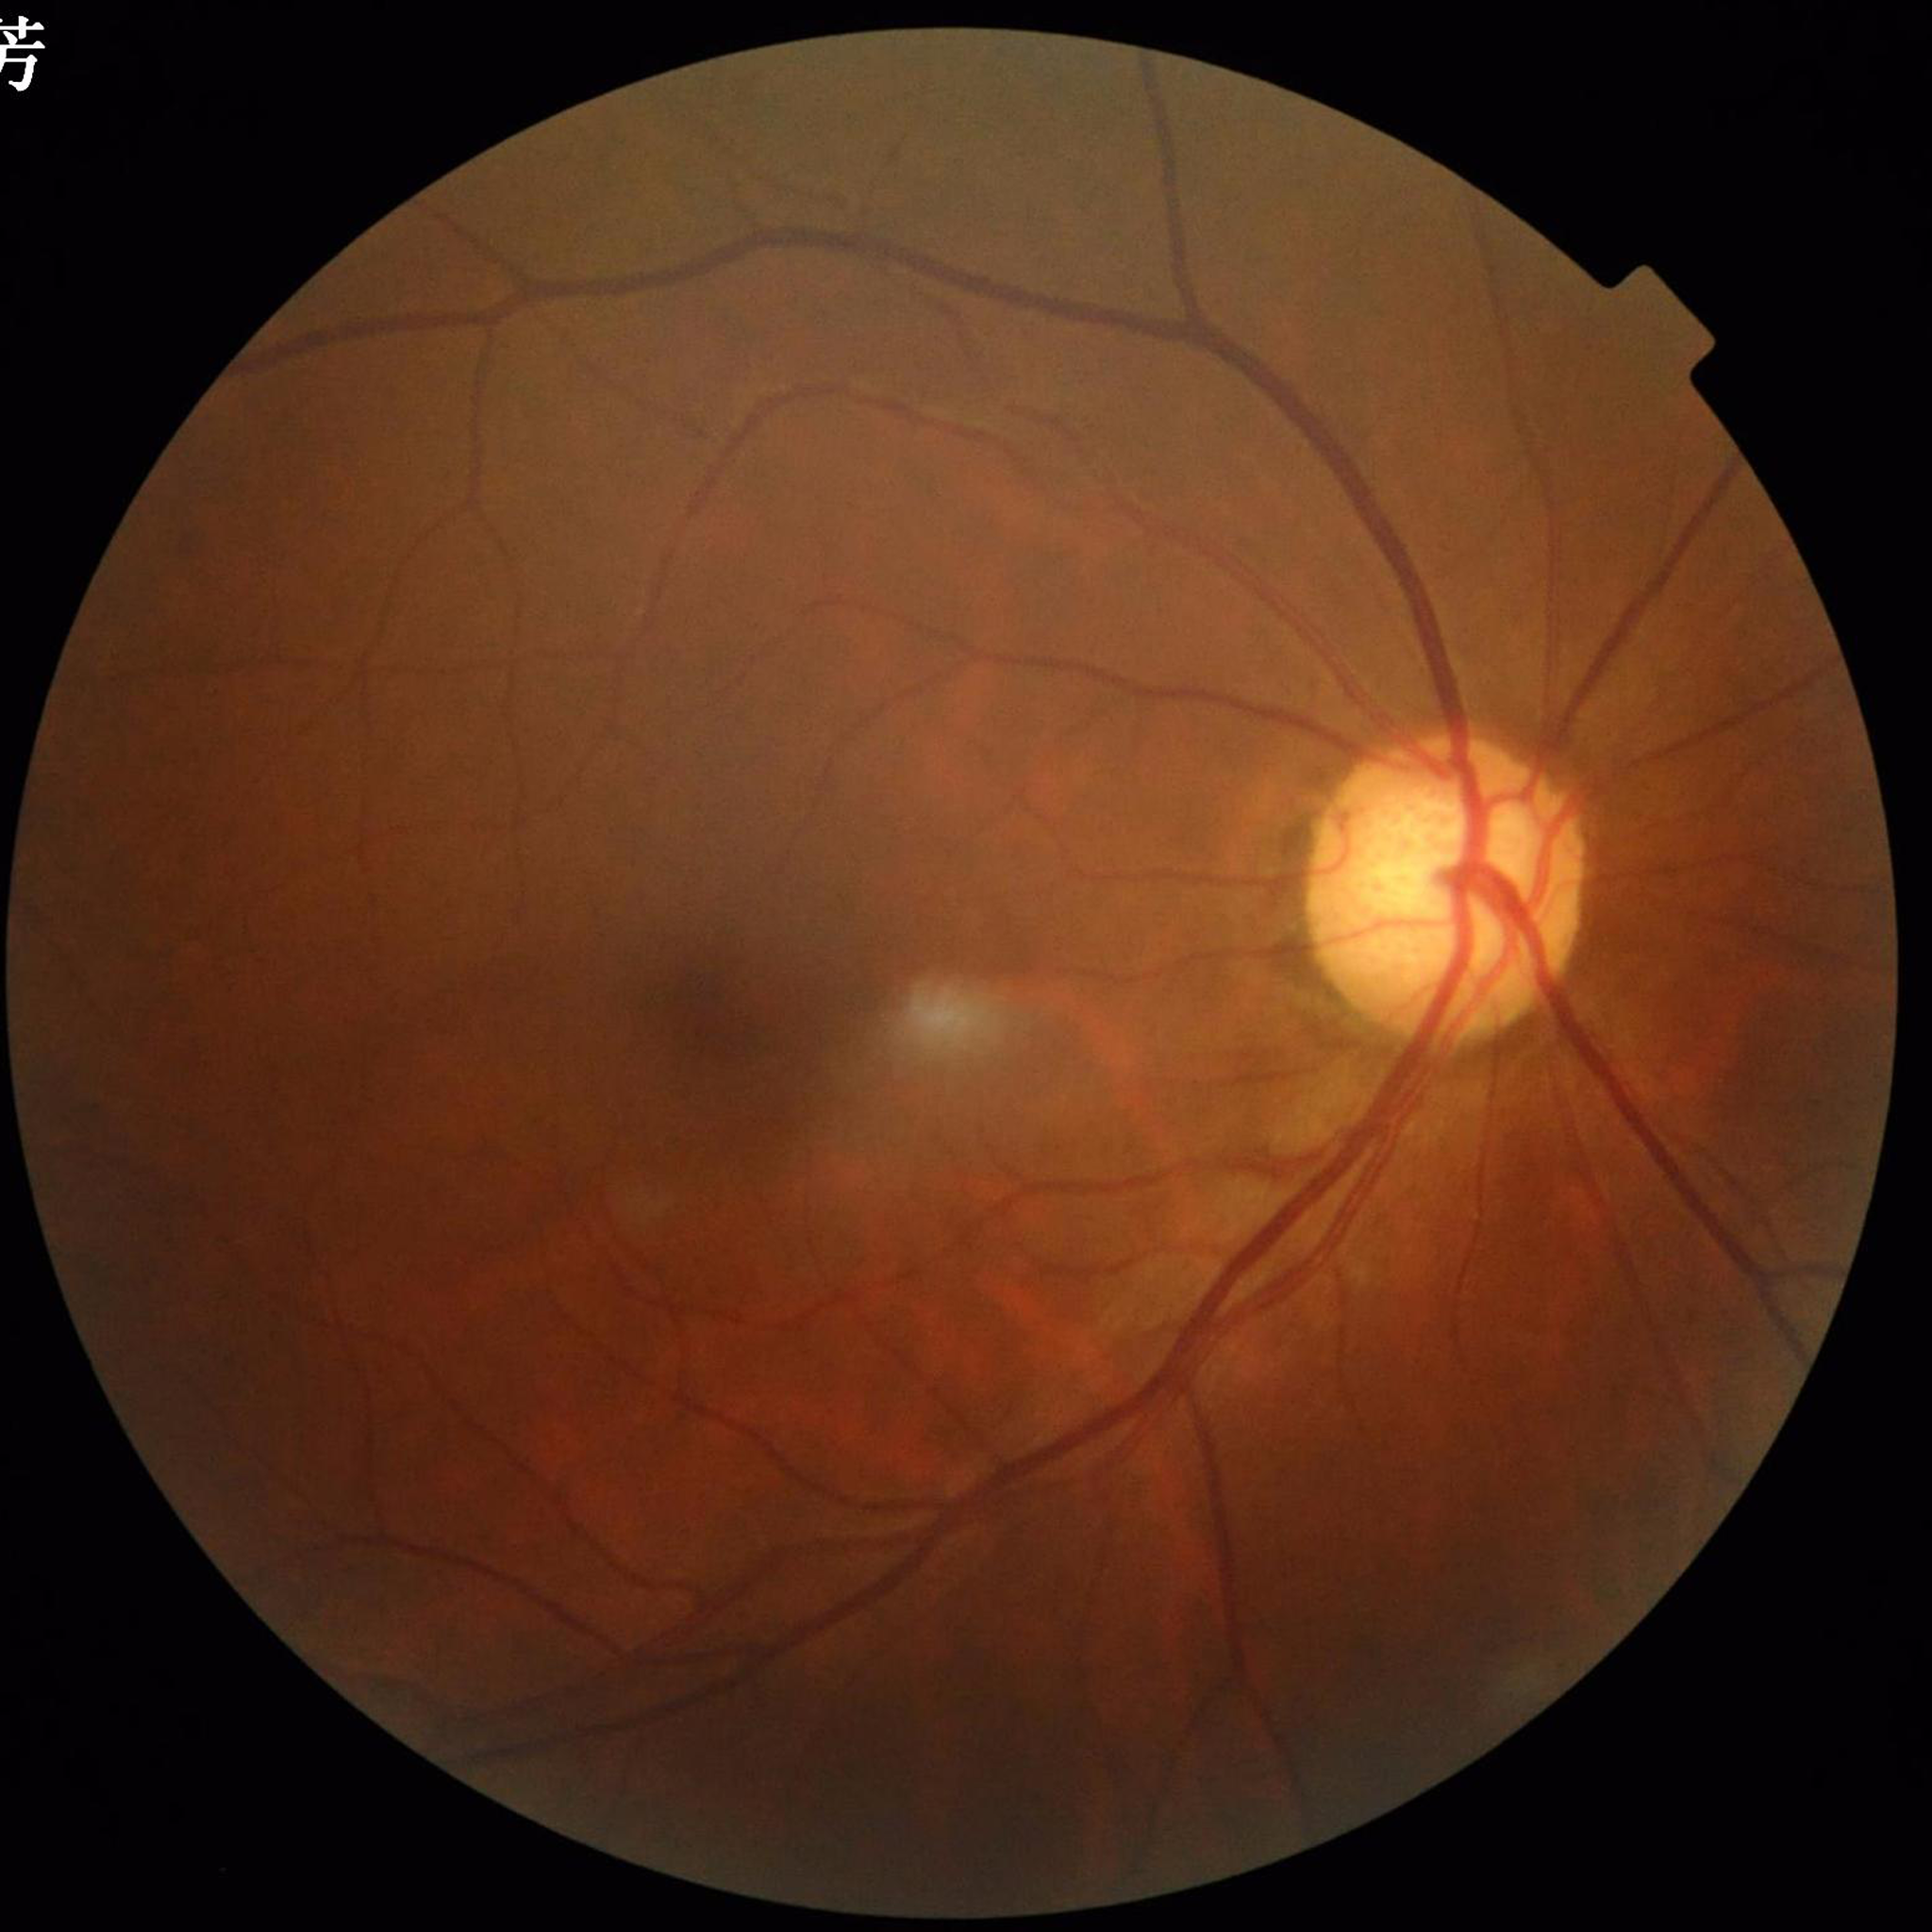
Impression: glaucoma.